No pharmacologic dilation · image size 848x848 · NIDEK AFC-230.
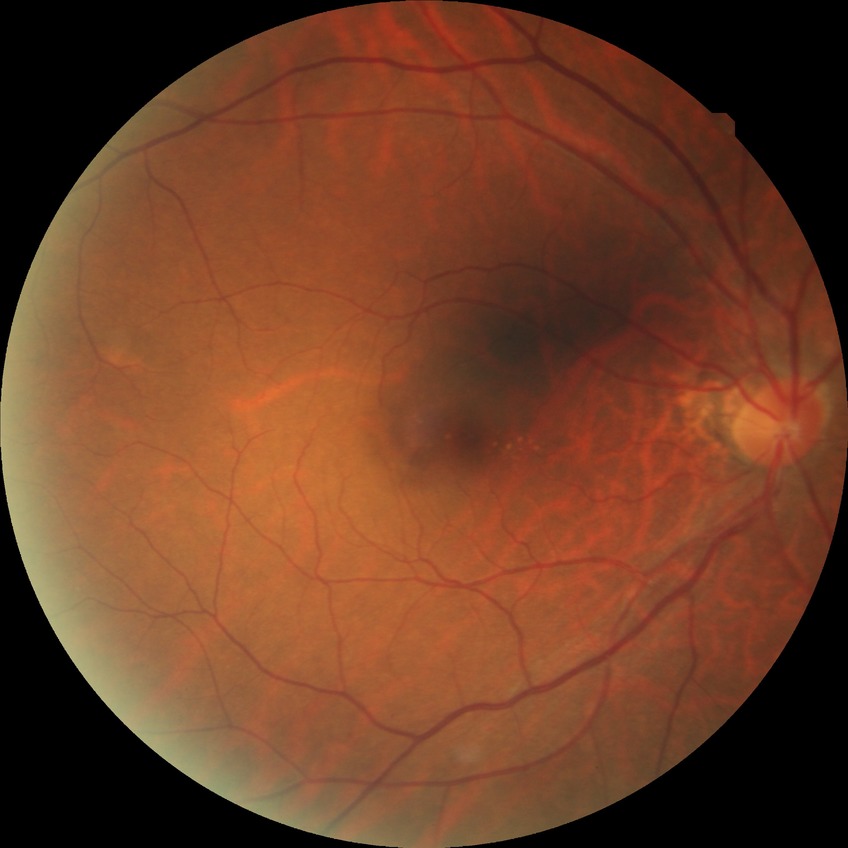
modified Davis grading=no diabetic retinopathy.